200° field of view; UWF retinal mosaic: 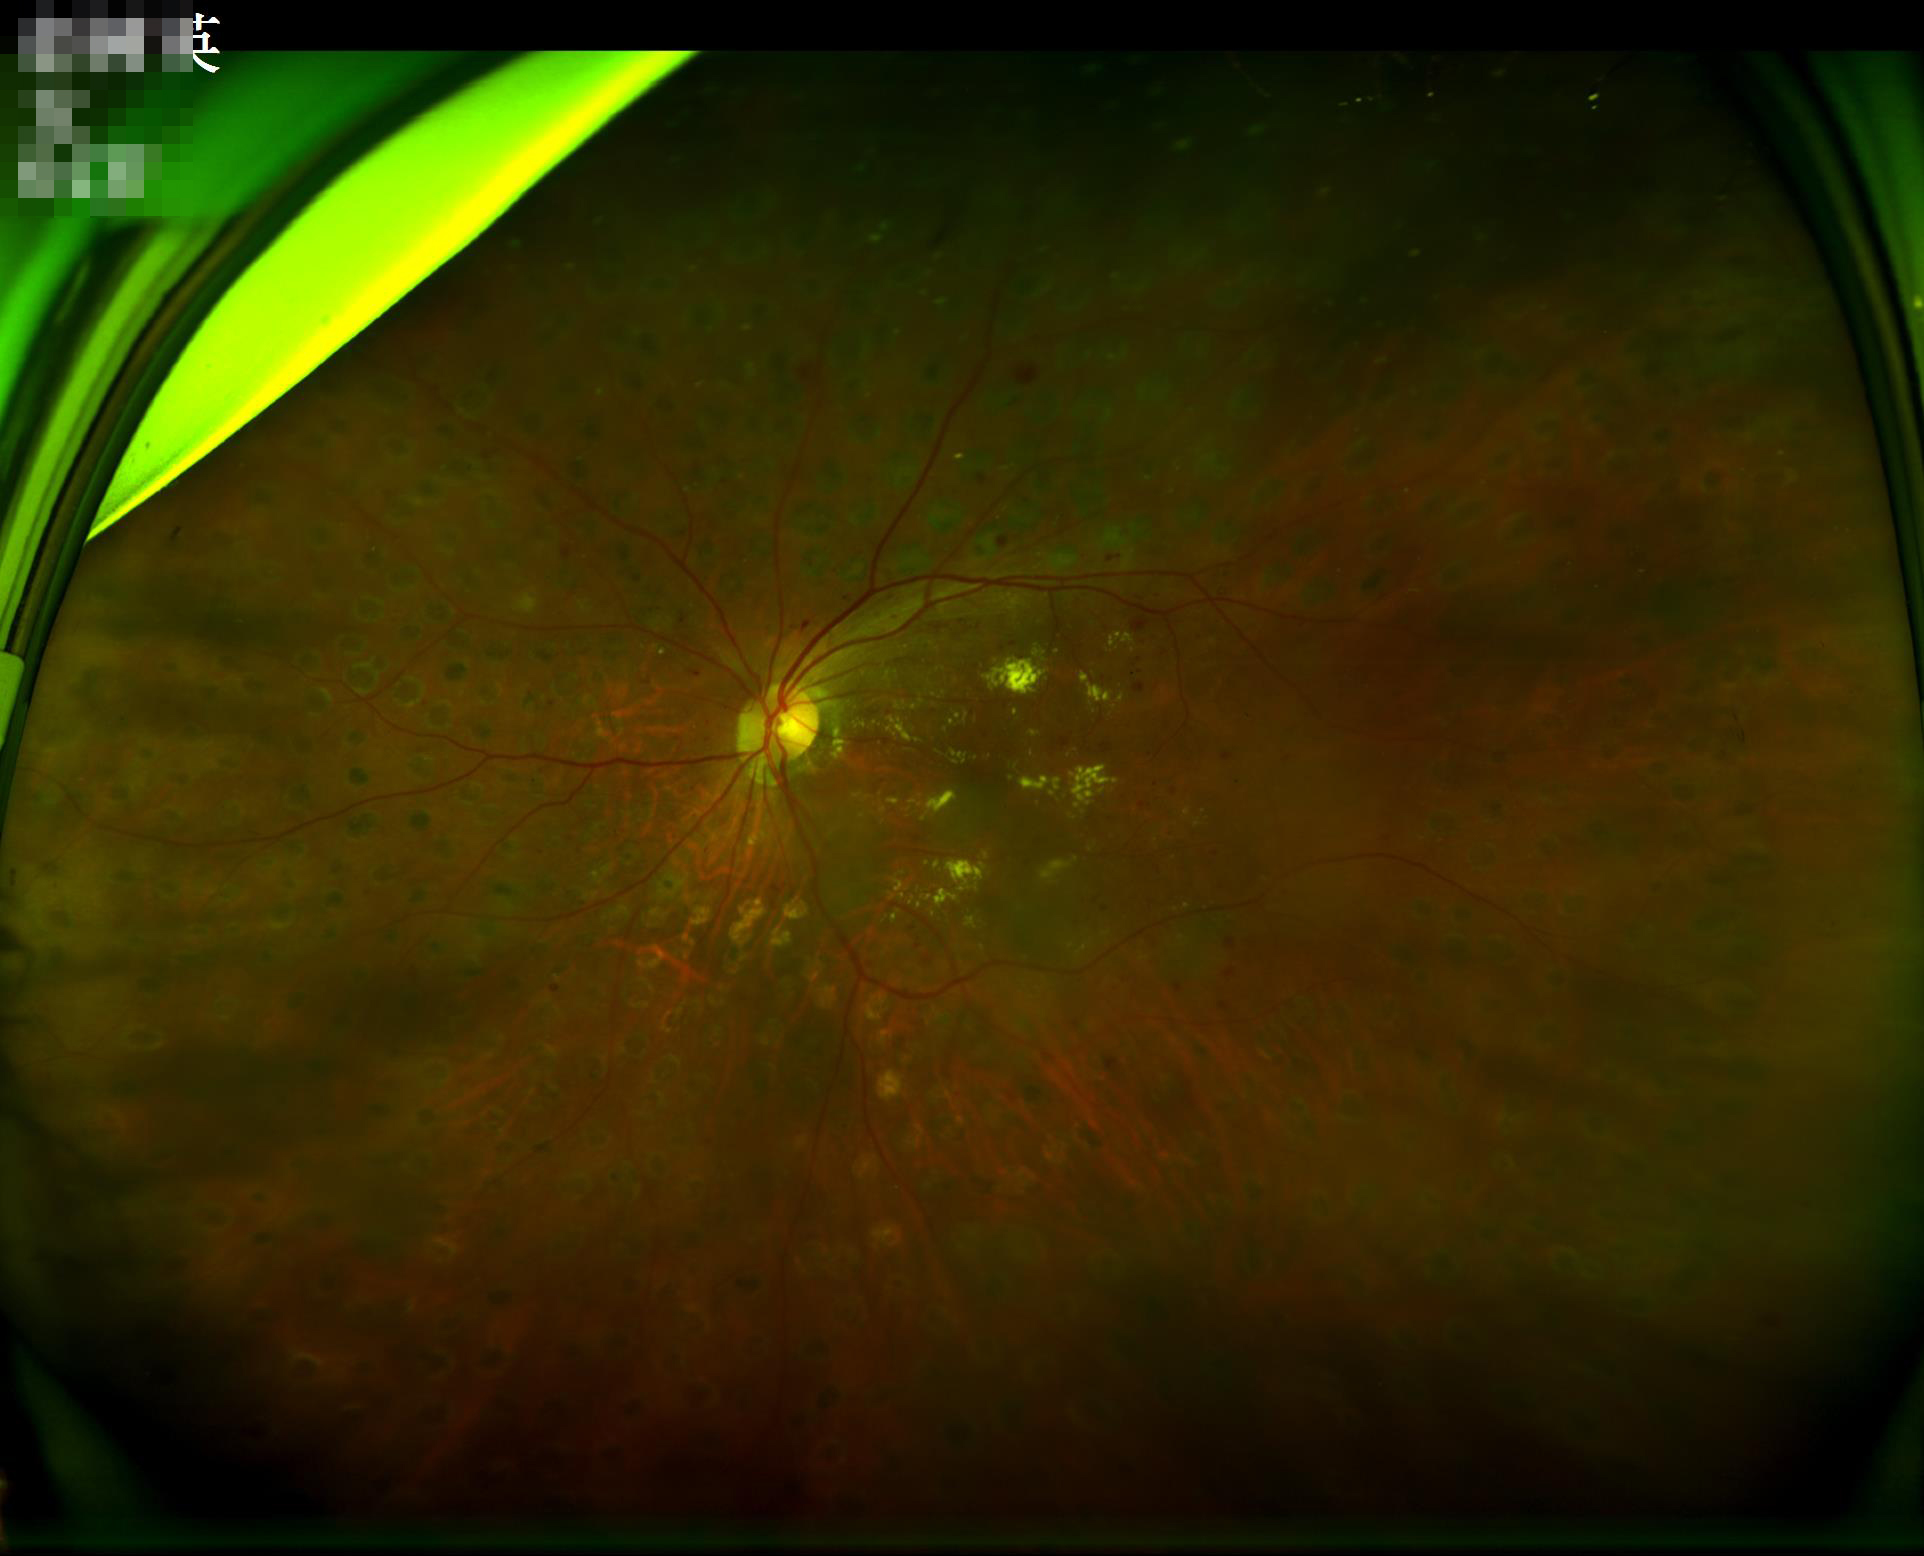
Image quality: contrast: satisfactory; clarity: clear; illumination: suboptimal; overall: good.